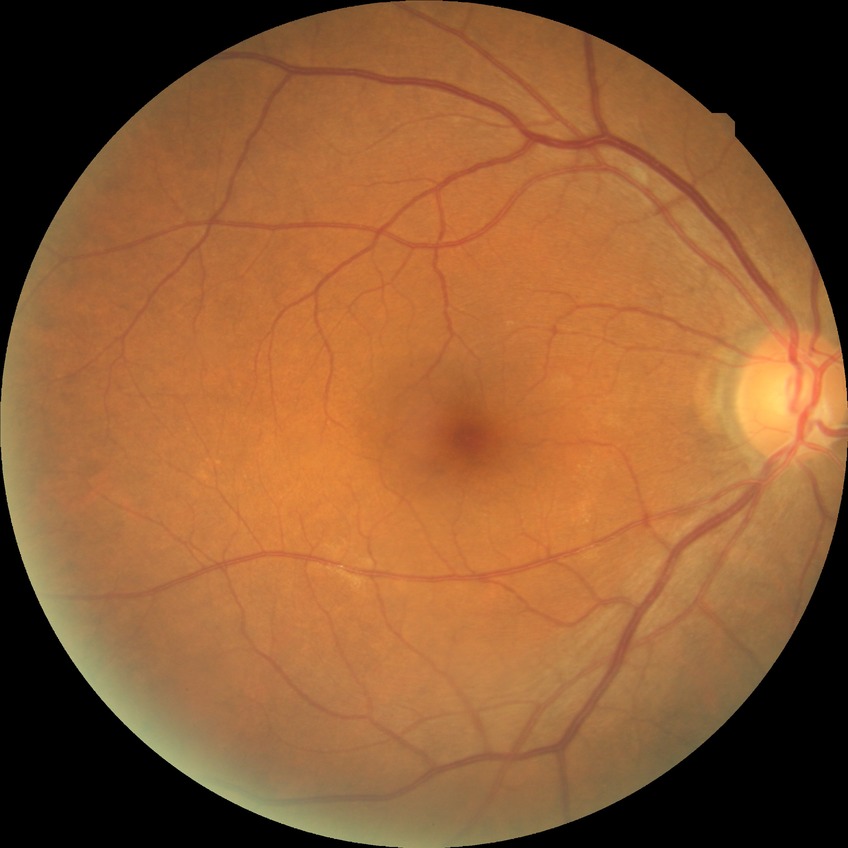

Assessment:
• DR impression: no apparent DR
• Davis DR grade: NDR